848 by 848 pixels
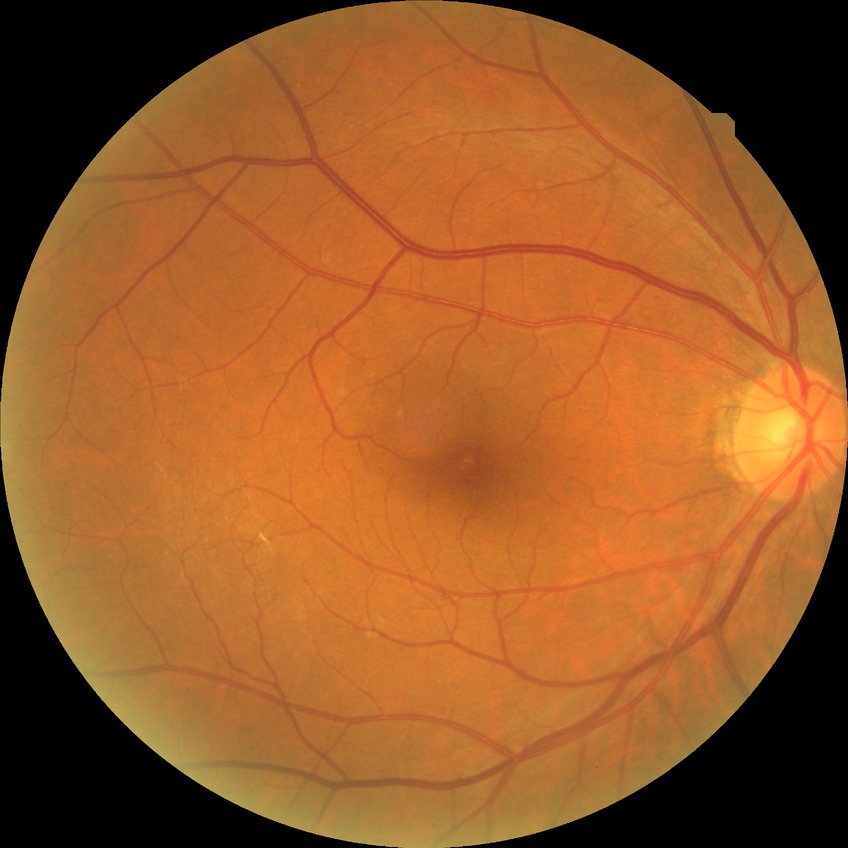
Davis stage: NDR.
No diabetic retinal disease findings.